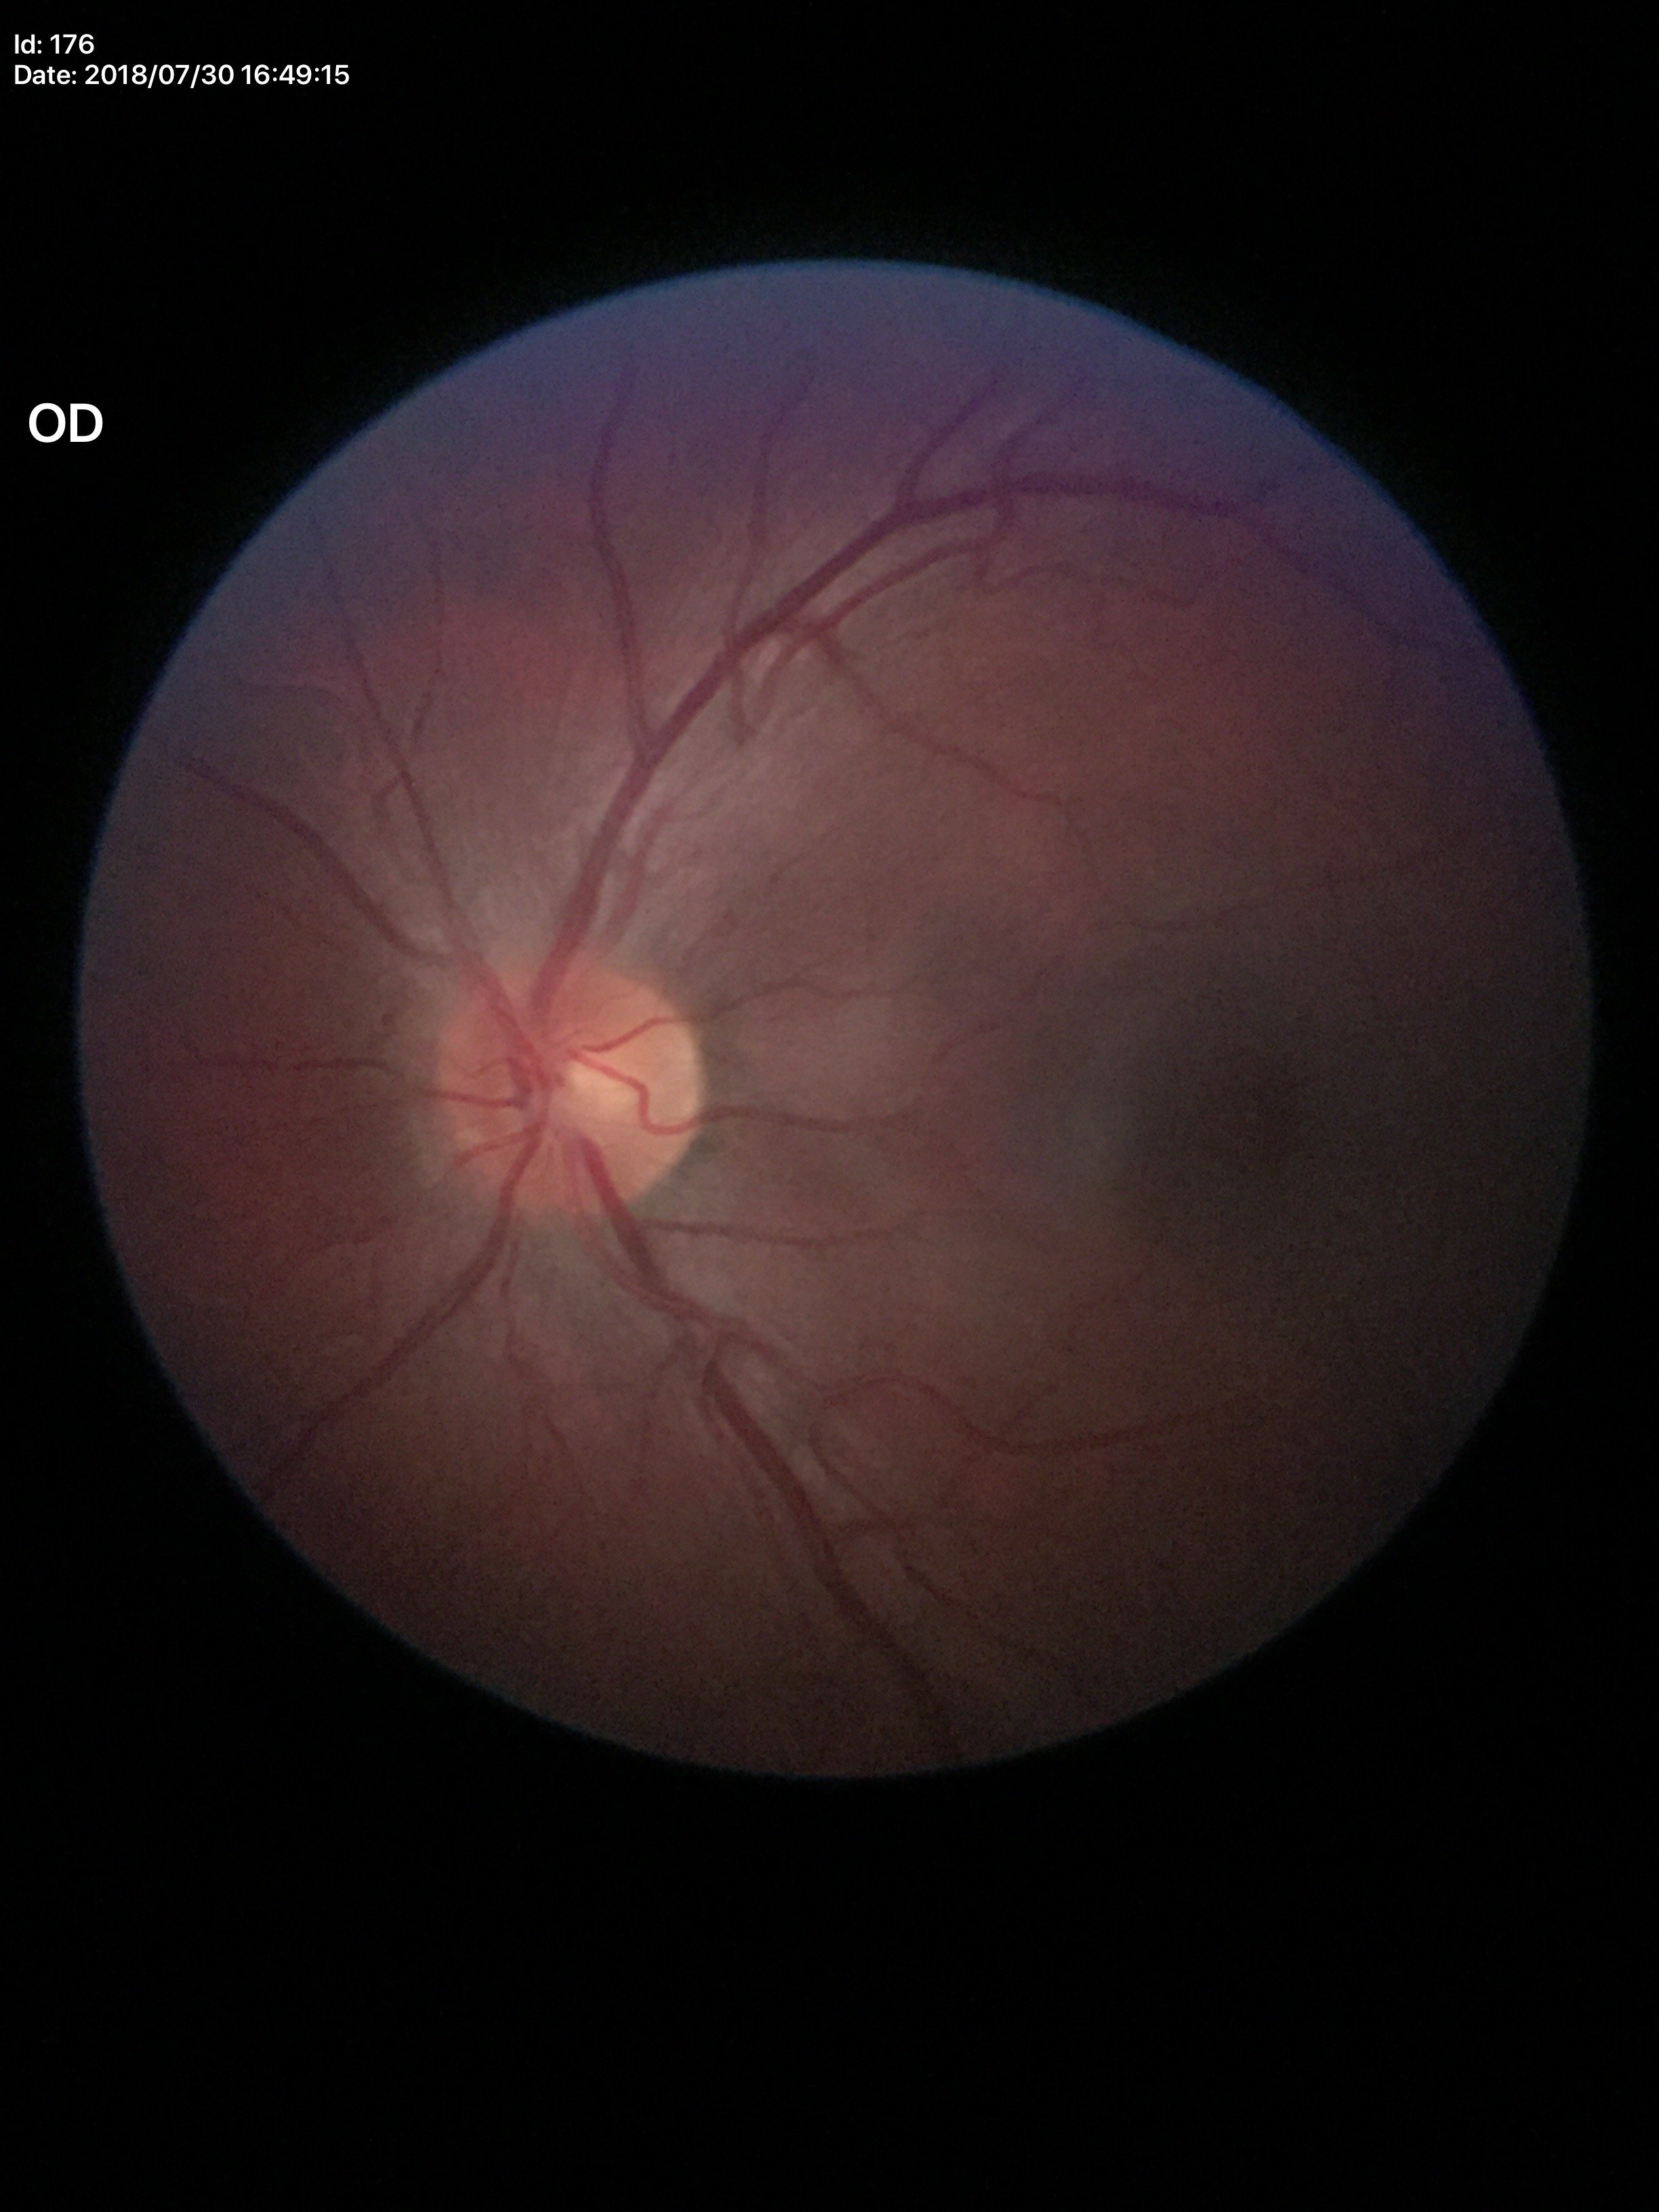

* Glaucoma impression: no suspicious findings (1/5 graders called glaucoma suspect)
* vertical cup-disc ratio: 0.50